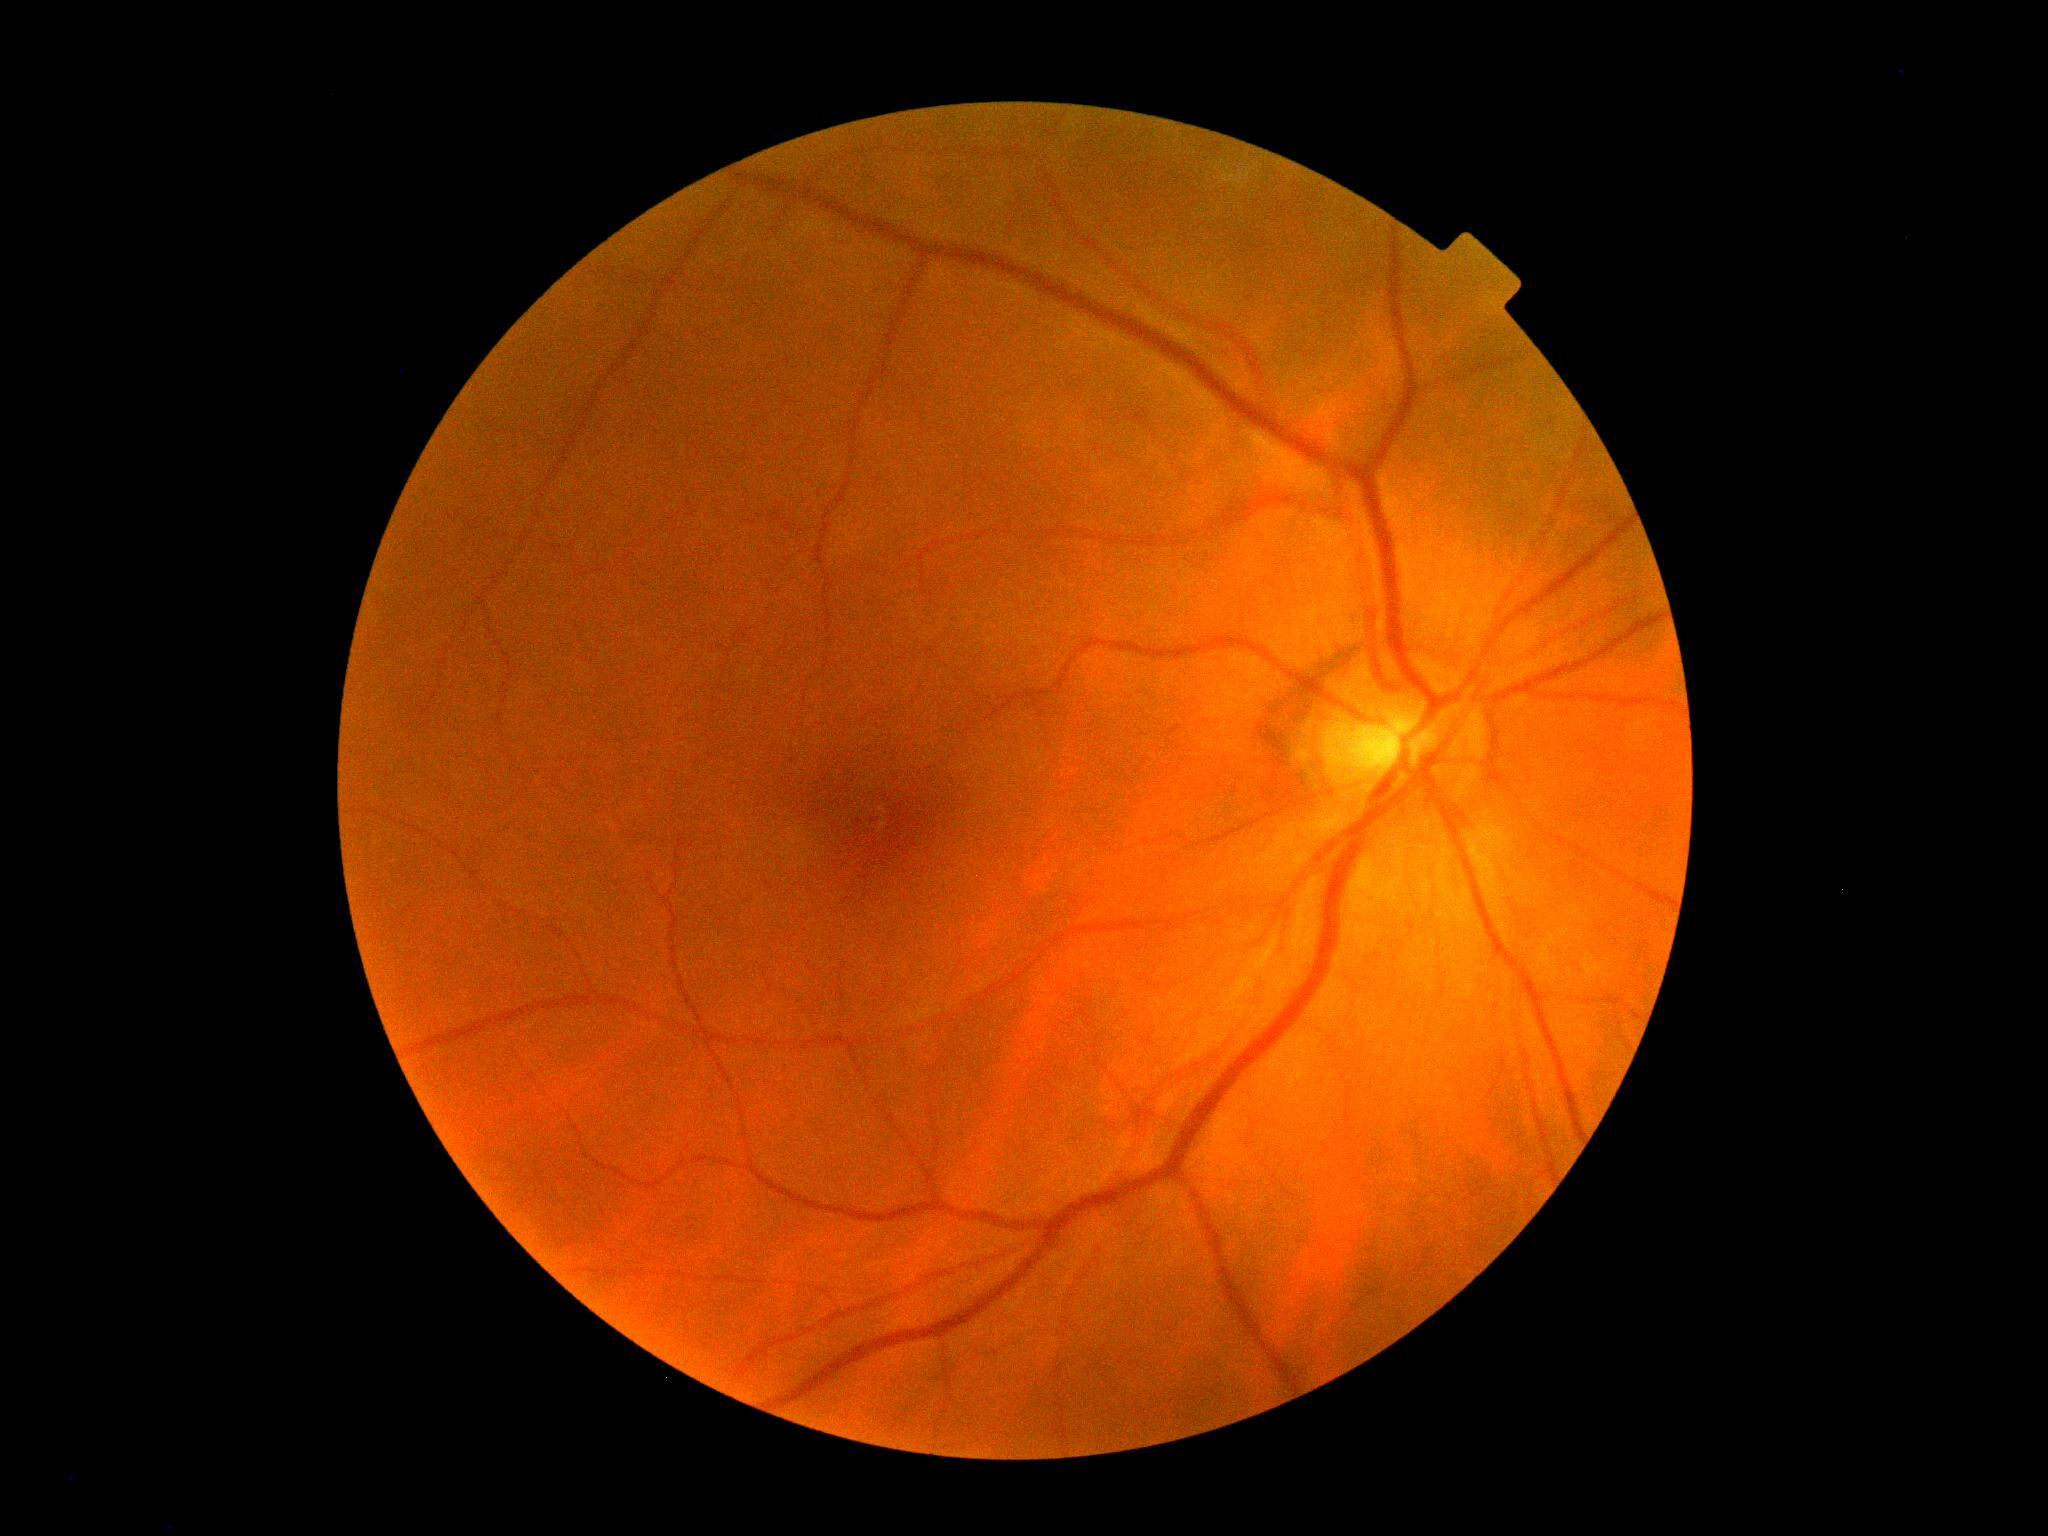 No DR findings. Diabetic retinopathy (DR): 0/4 — no visible signs of diabetic retinopathy.